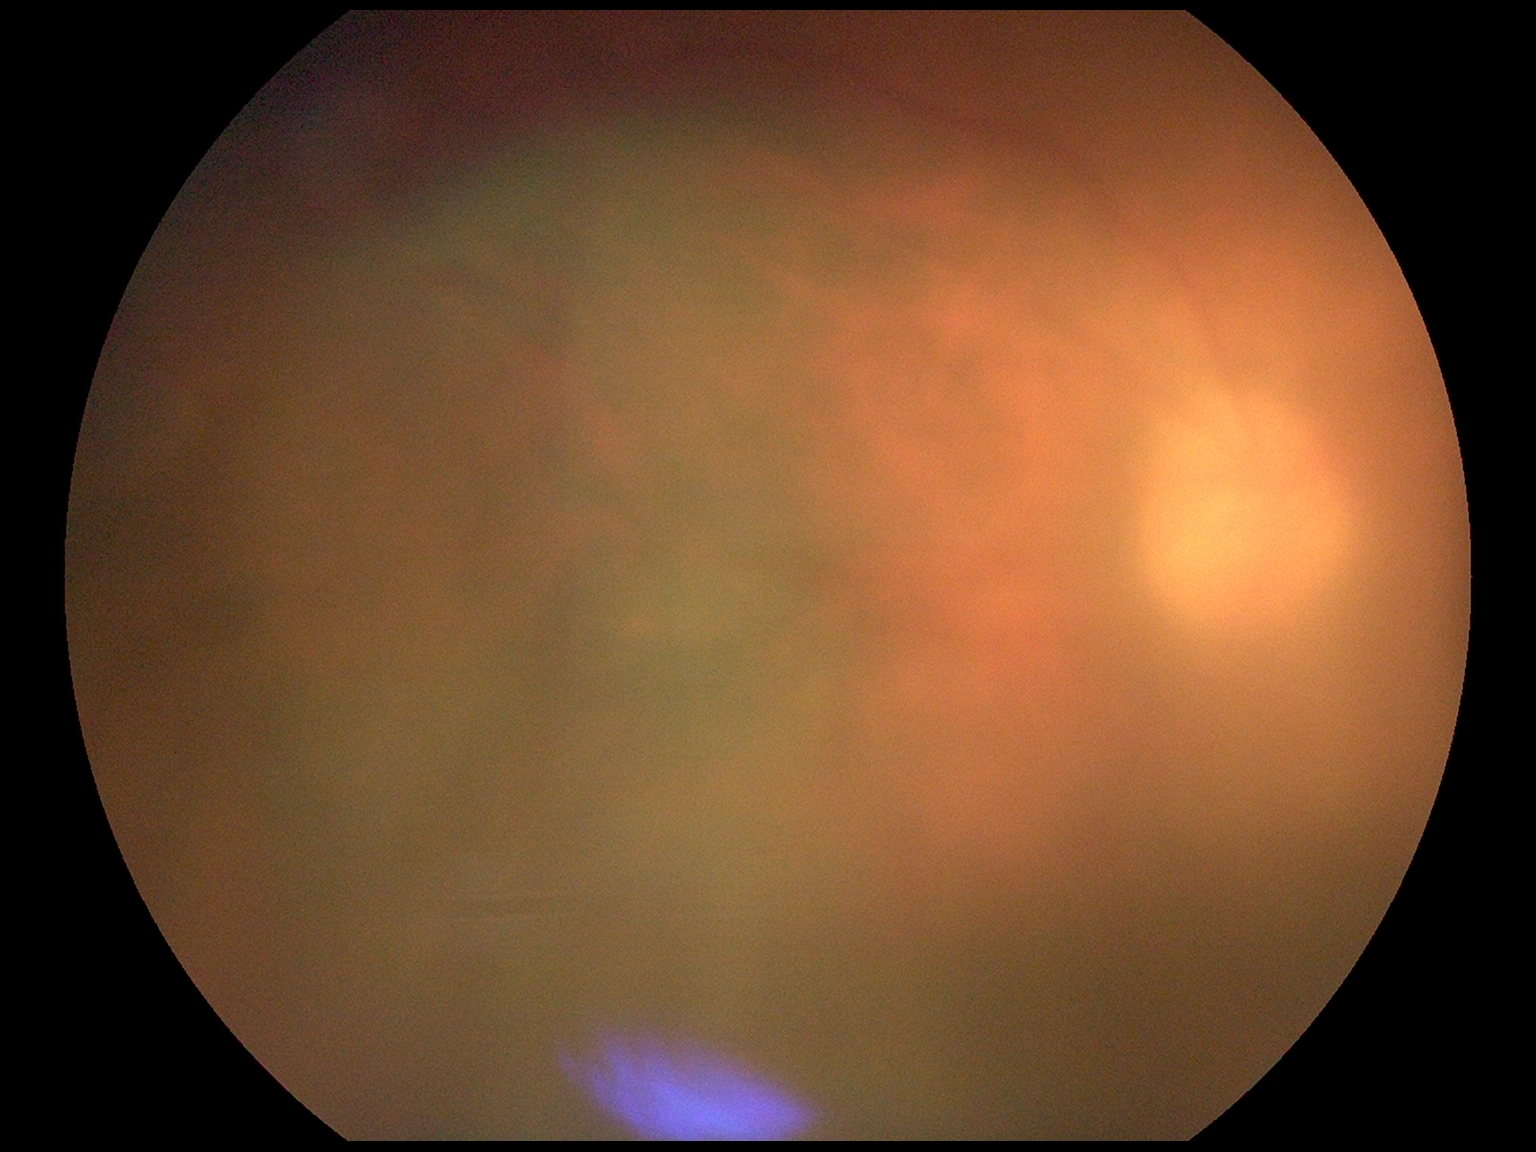 – image quality: below grading threshold
– DR grade: ungradable due to poor image quality